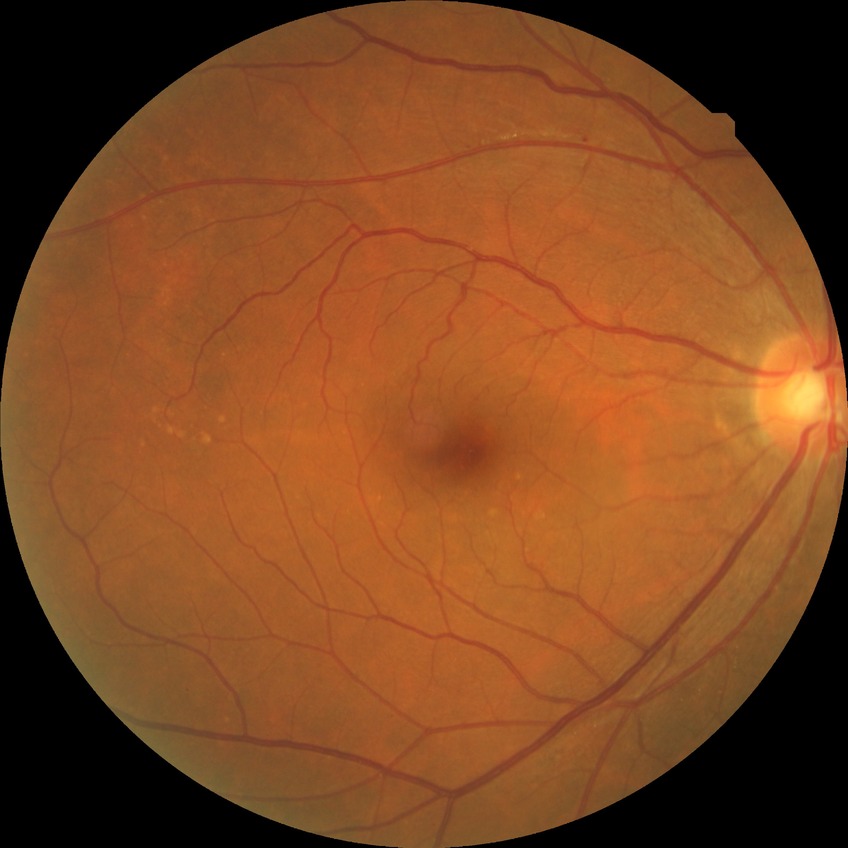
Davis grading=no diabetic retinopathy.